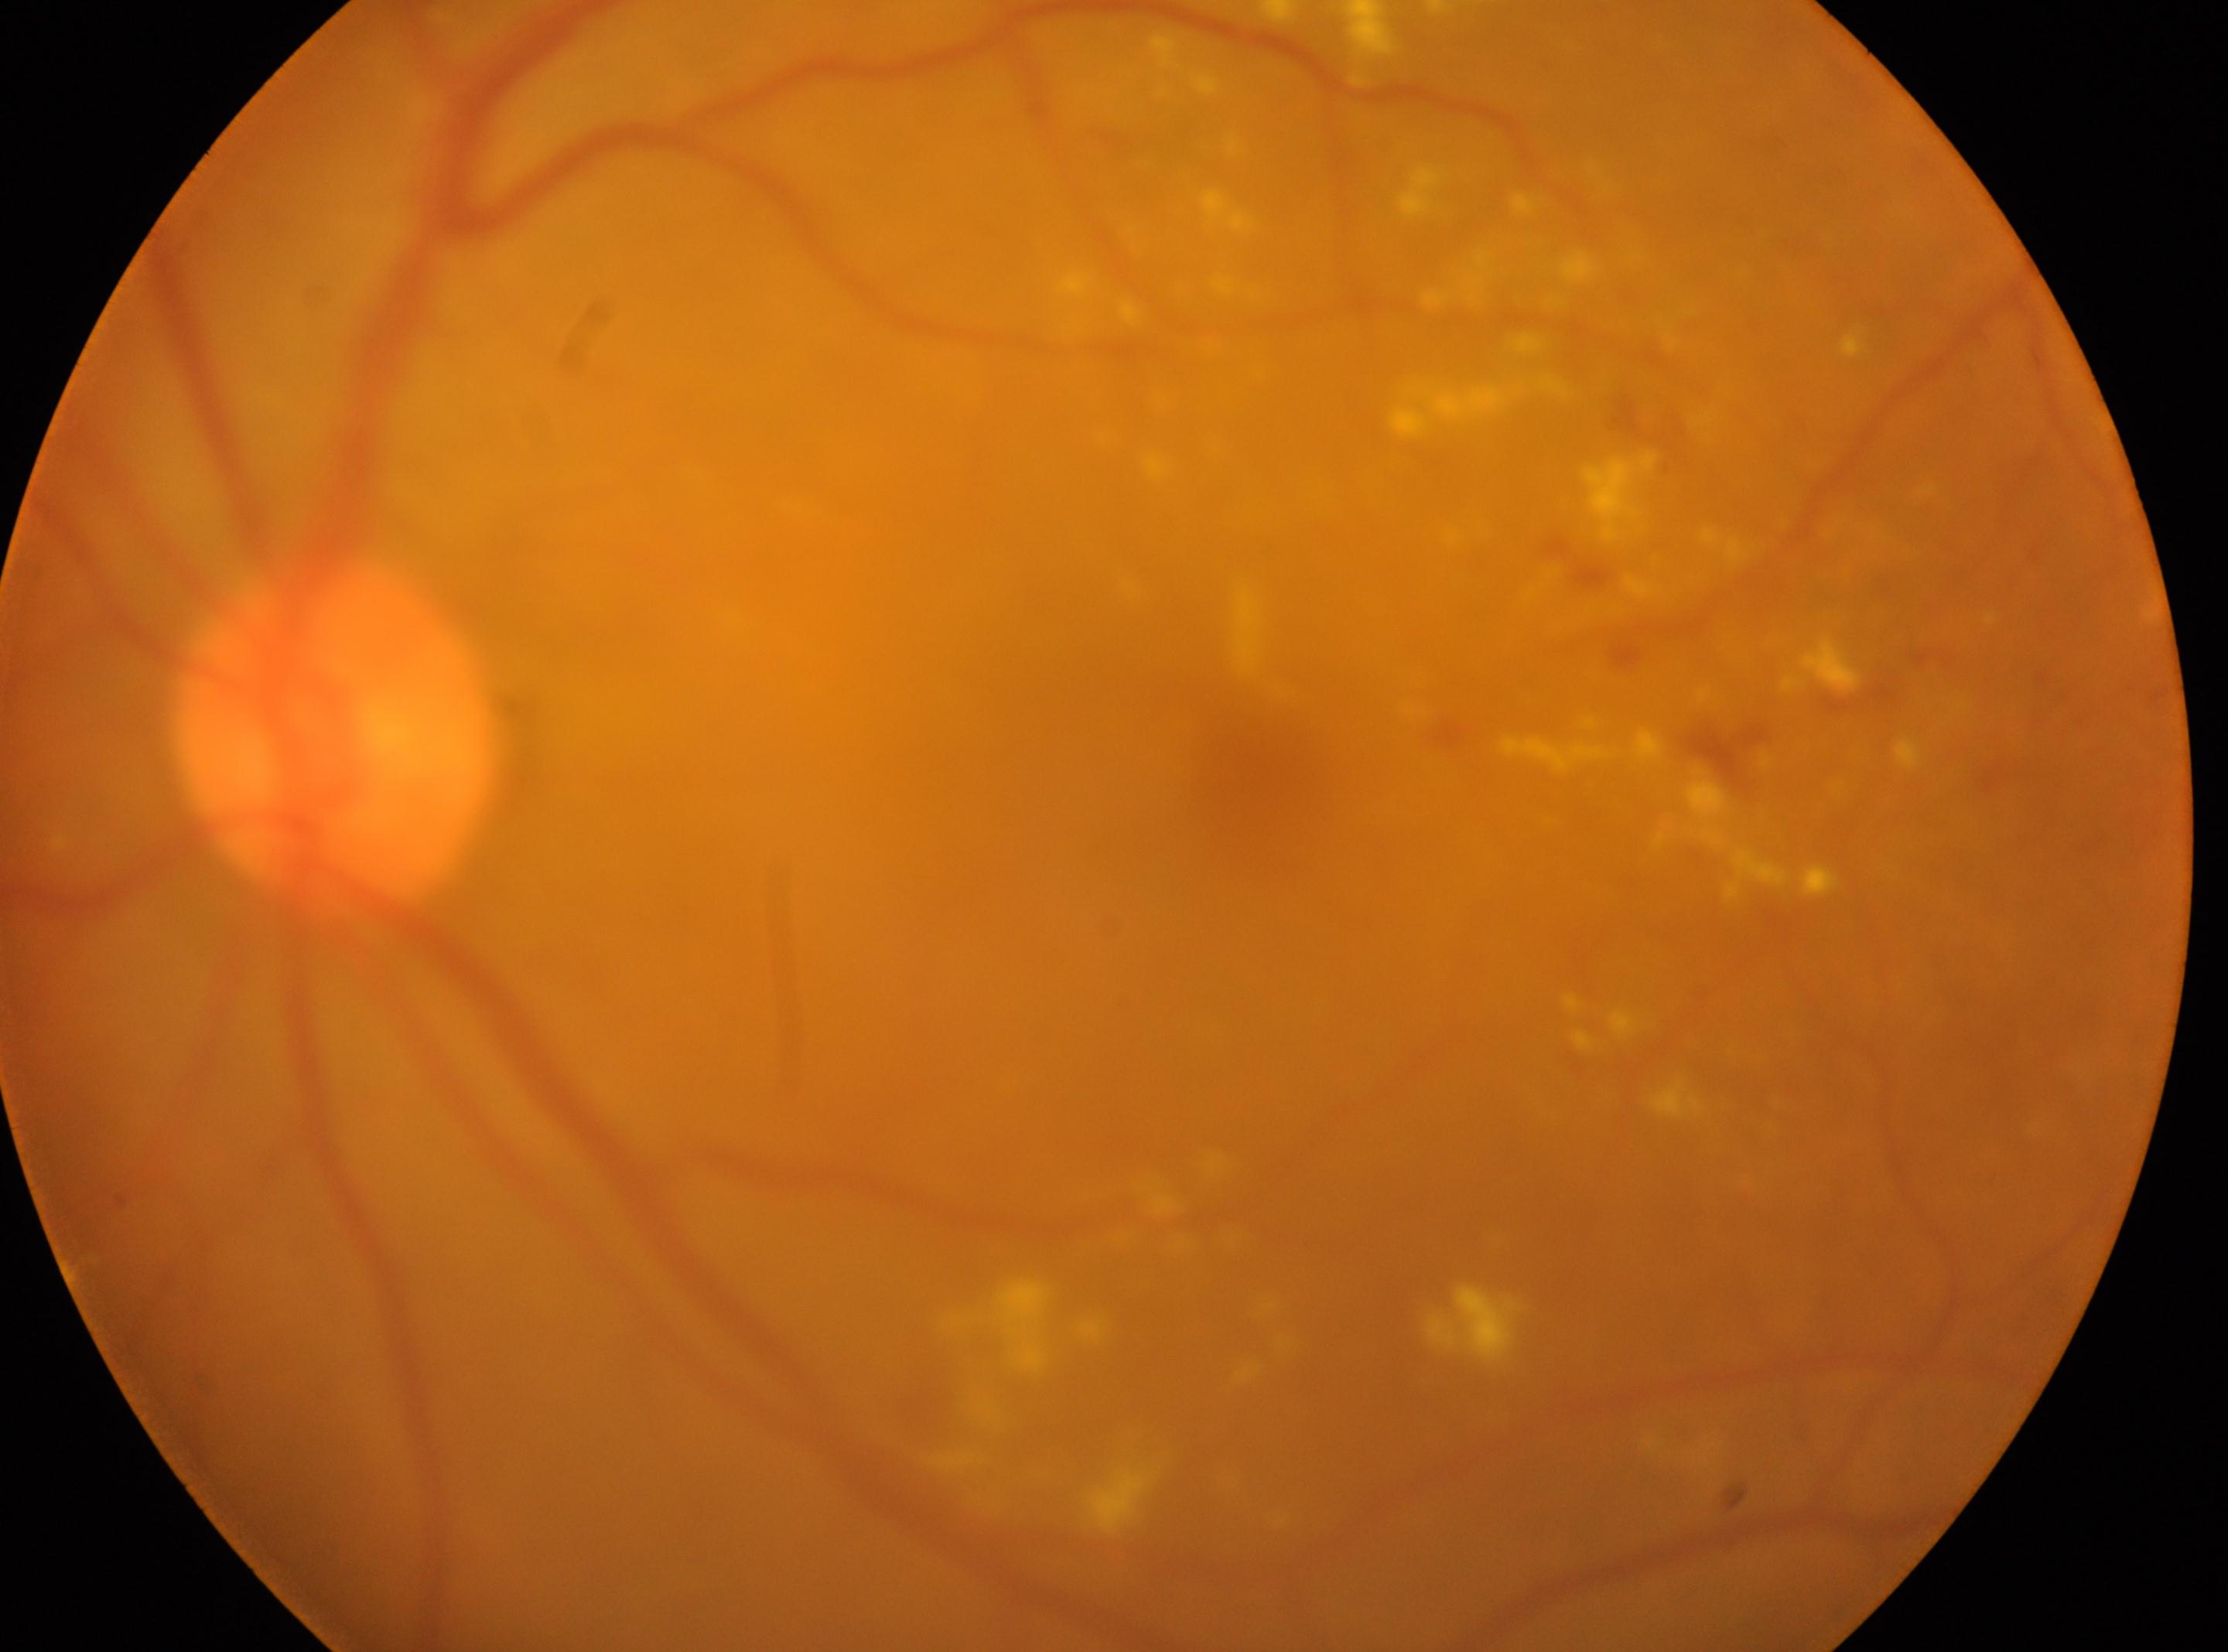
diabetic retinopathy grade=2/4 | oculus sinister | optic nerve head=[333, 735] | macula center=[1263, 767].